Fundus photo — 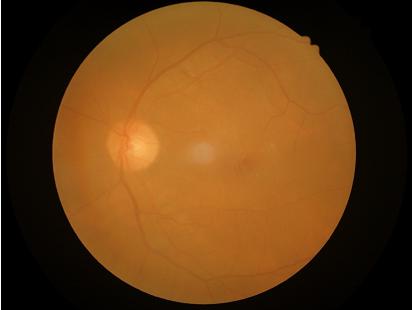

Even illumination with no color cast.
Out of focus; structures are indistinct.
Poor dynamic range.
Overall quality is poor; the image is difficult to grade.